Remidio smartphone fundus camera — 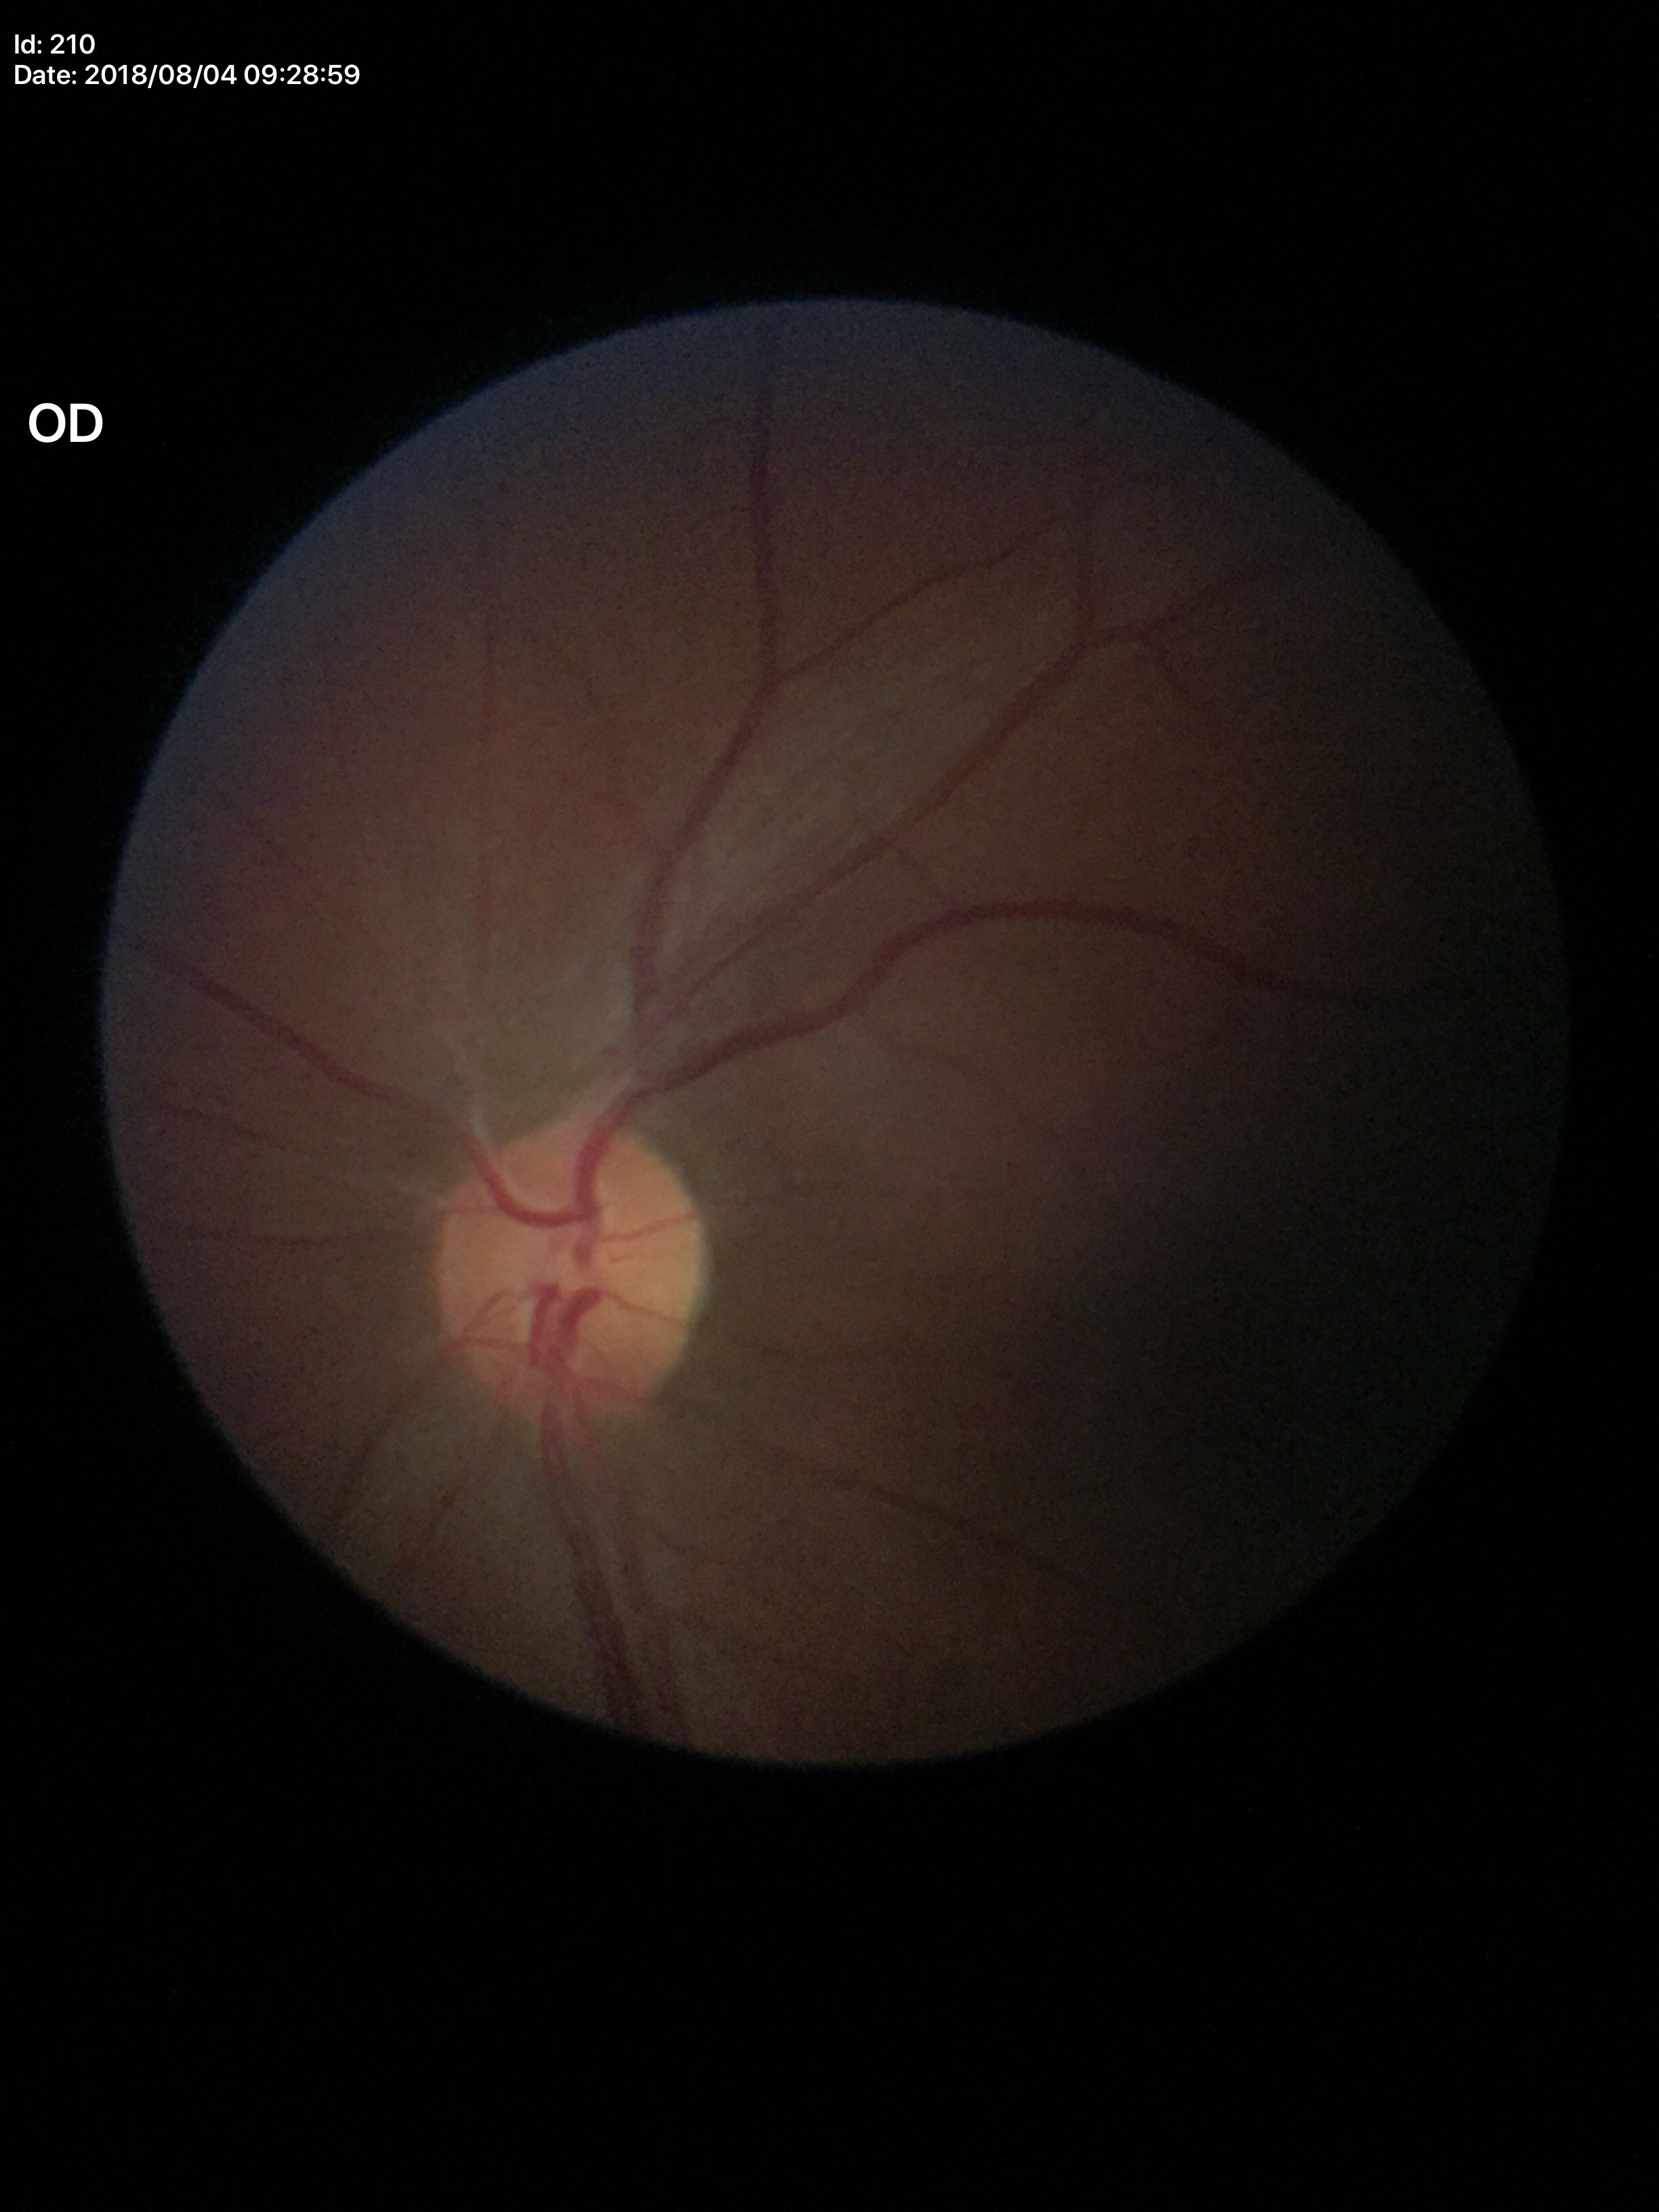
vertical cup-disc ratio = 0.41 | horizontal cup-to-disc ratio = 0.47 | Glaucoma screening = negative.